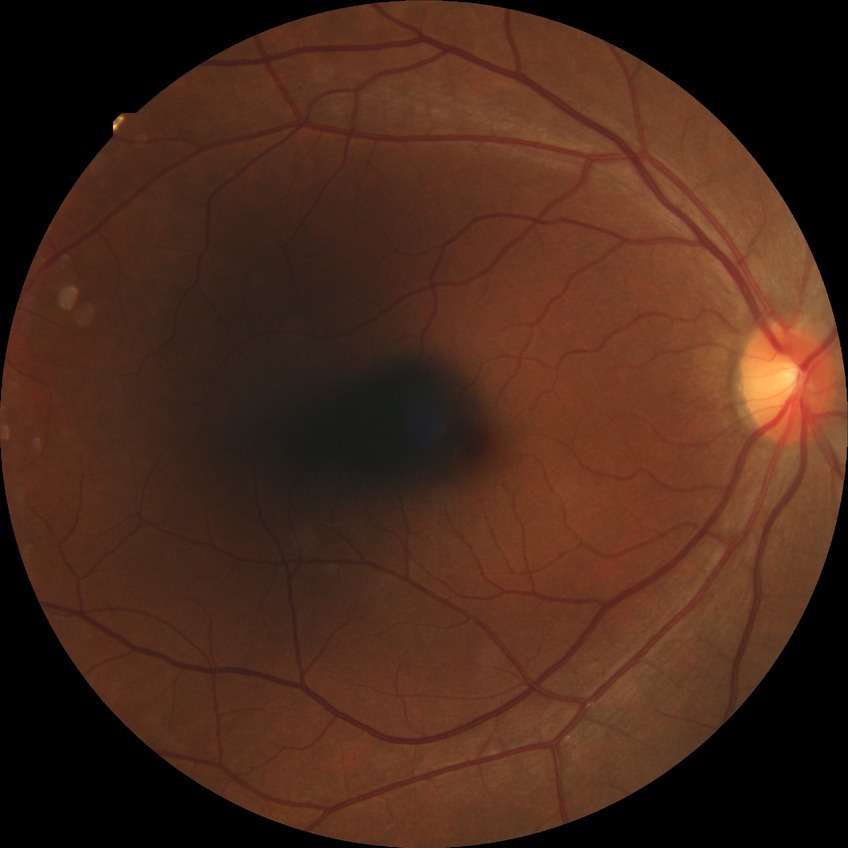

Diabetic retinopathy severity: no diabetic retinopathy.